1932 by 1932 pixels · color fundus image · 50° field of view
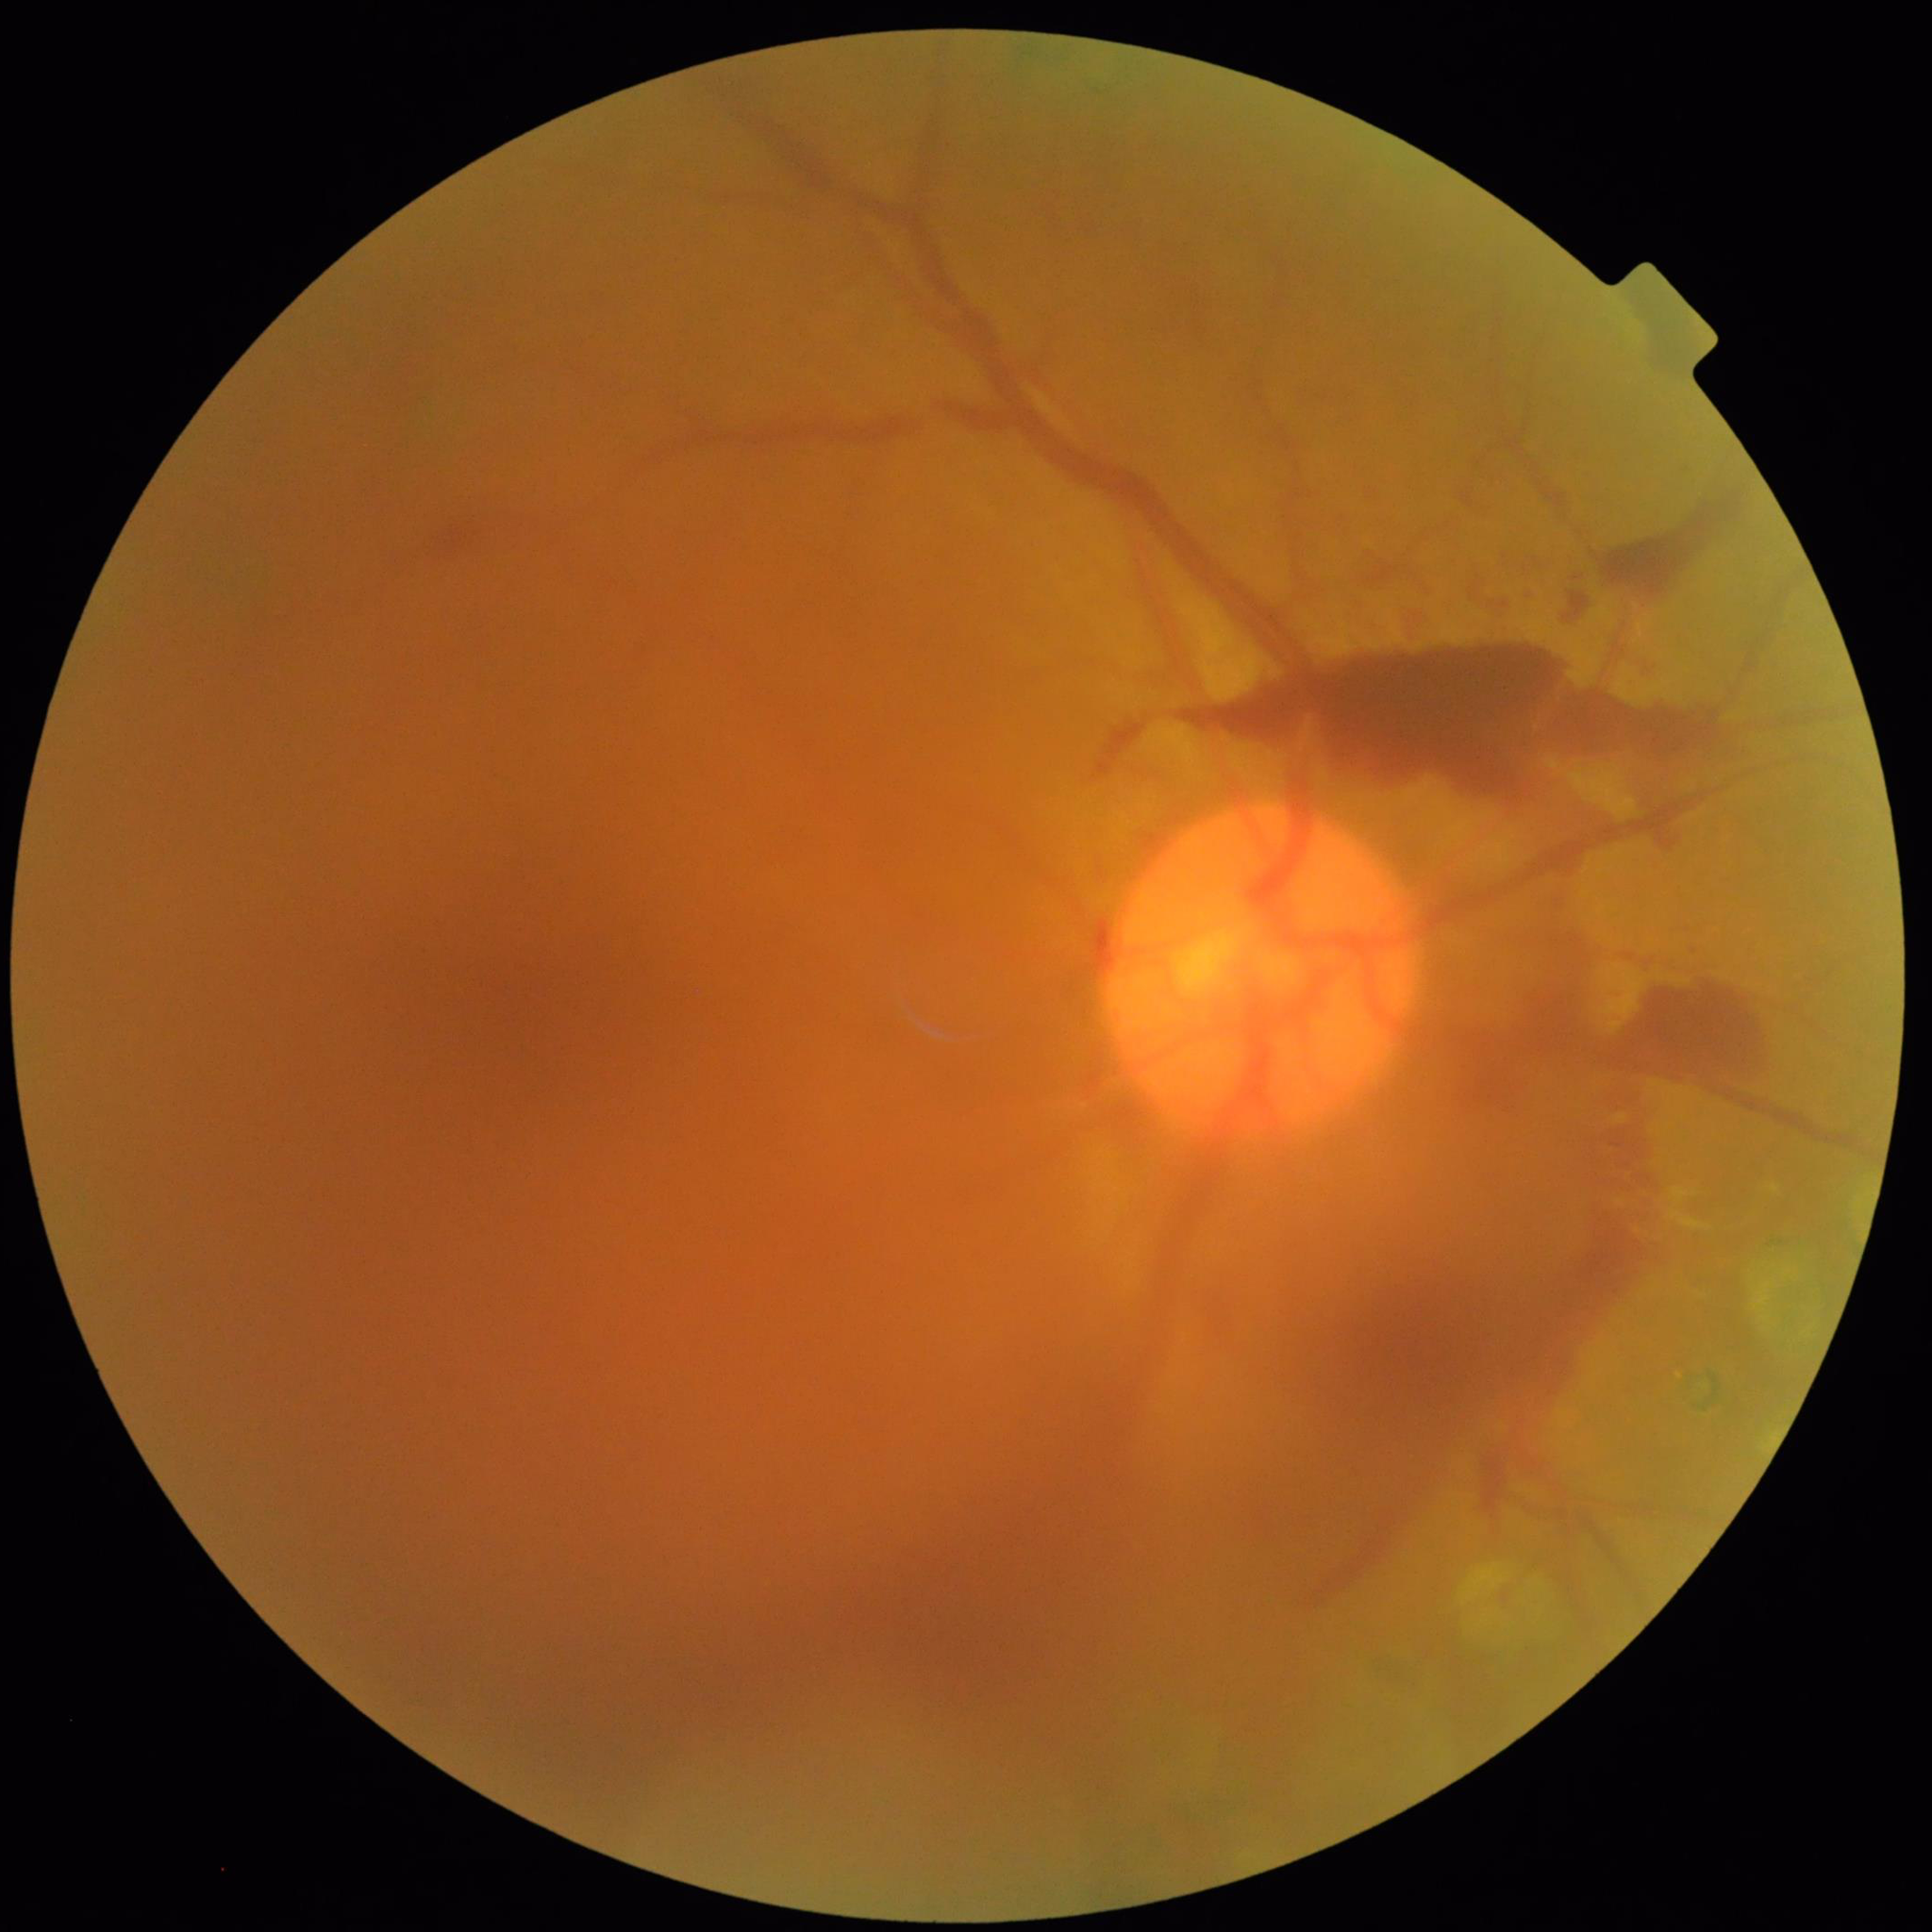 Eye affected by DR. Quality: illumination/color distortion present, contrast adequate, blur present.